Dilated-pupil acquisition. FOV: 50 degrees. Central posterior field. Camera: Topcon TRC-50DX. 2228 x 1652 pixels. CFP:
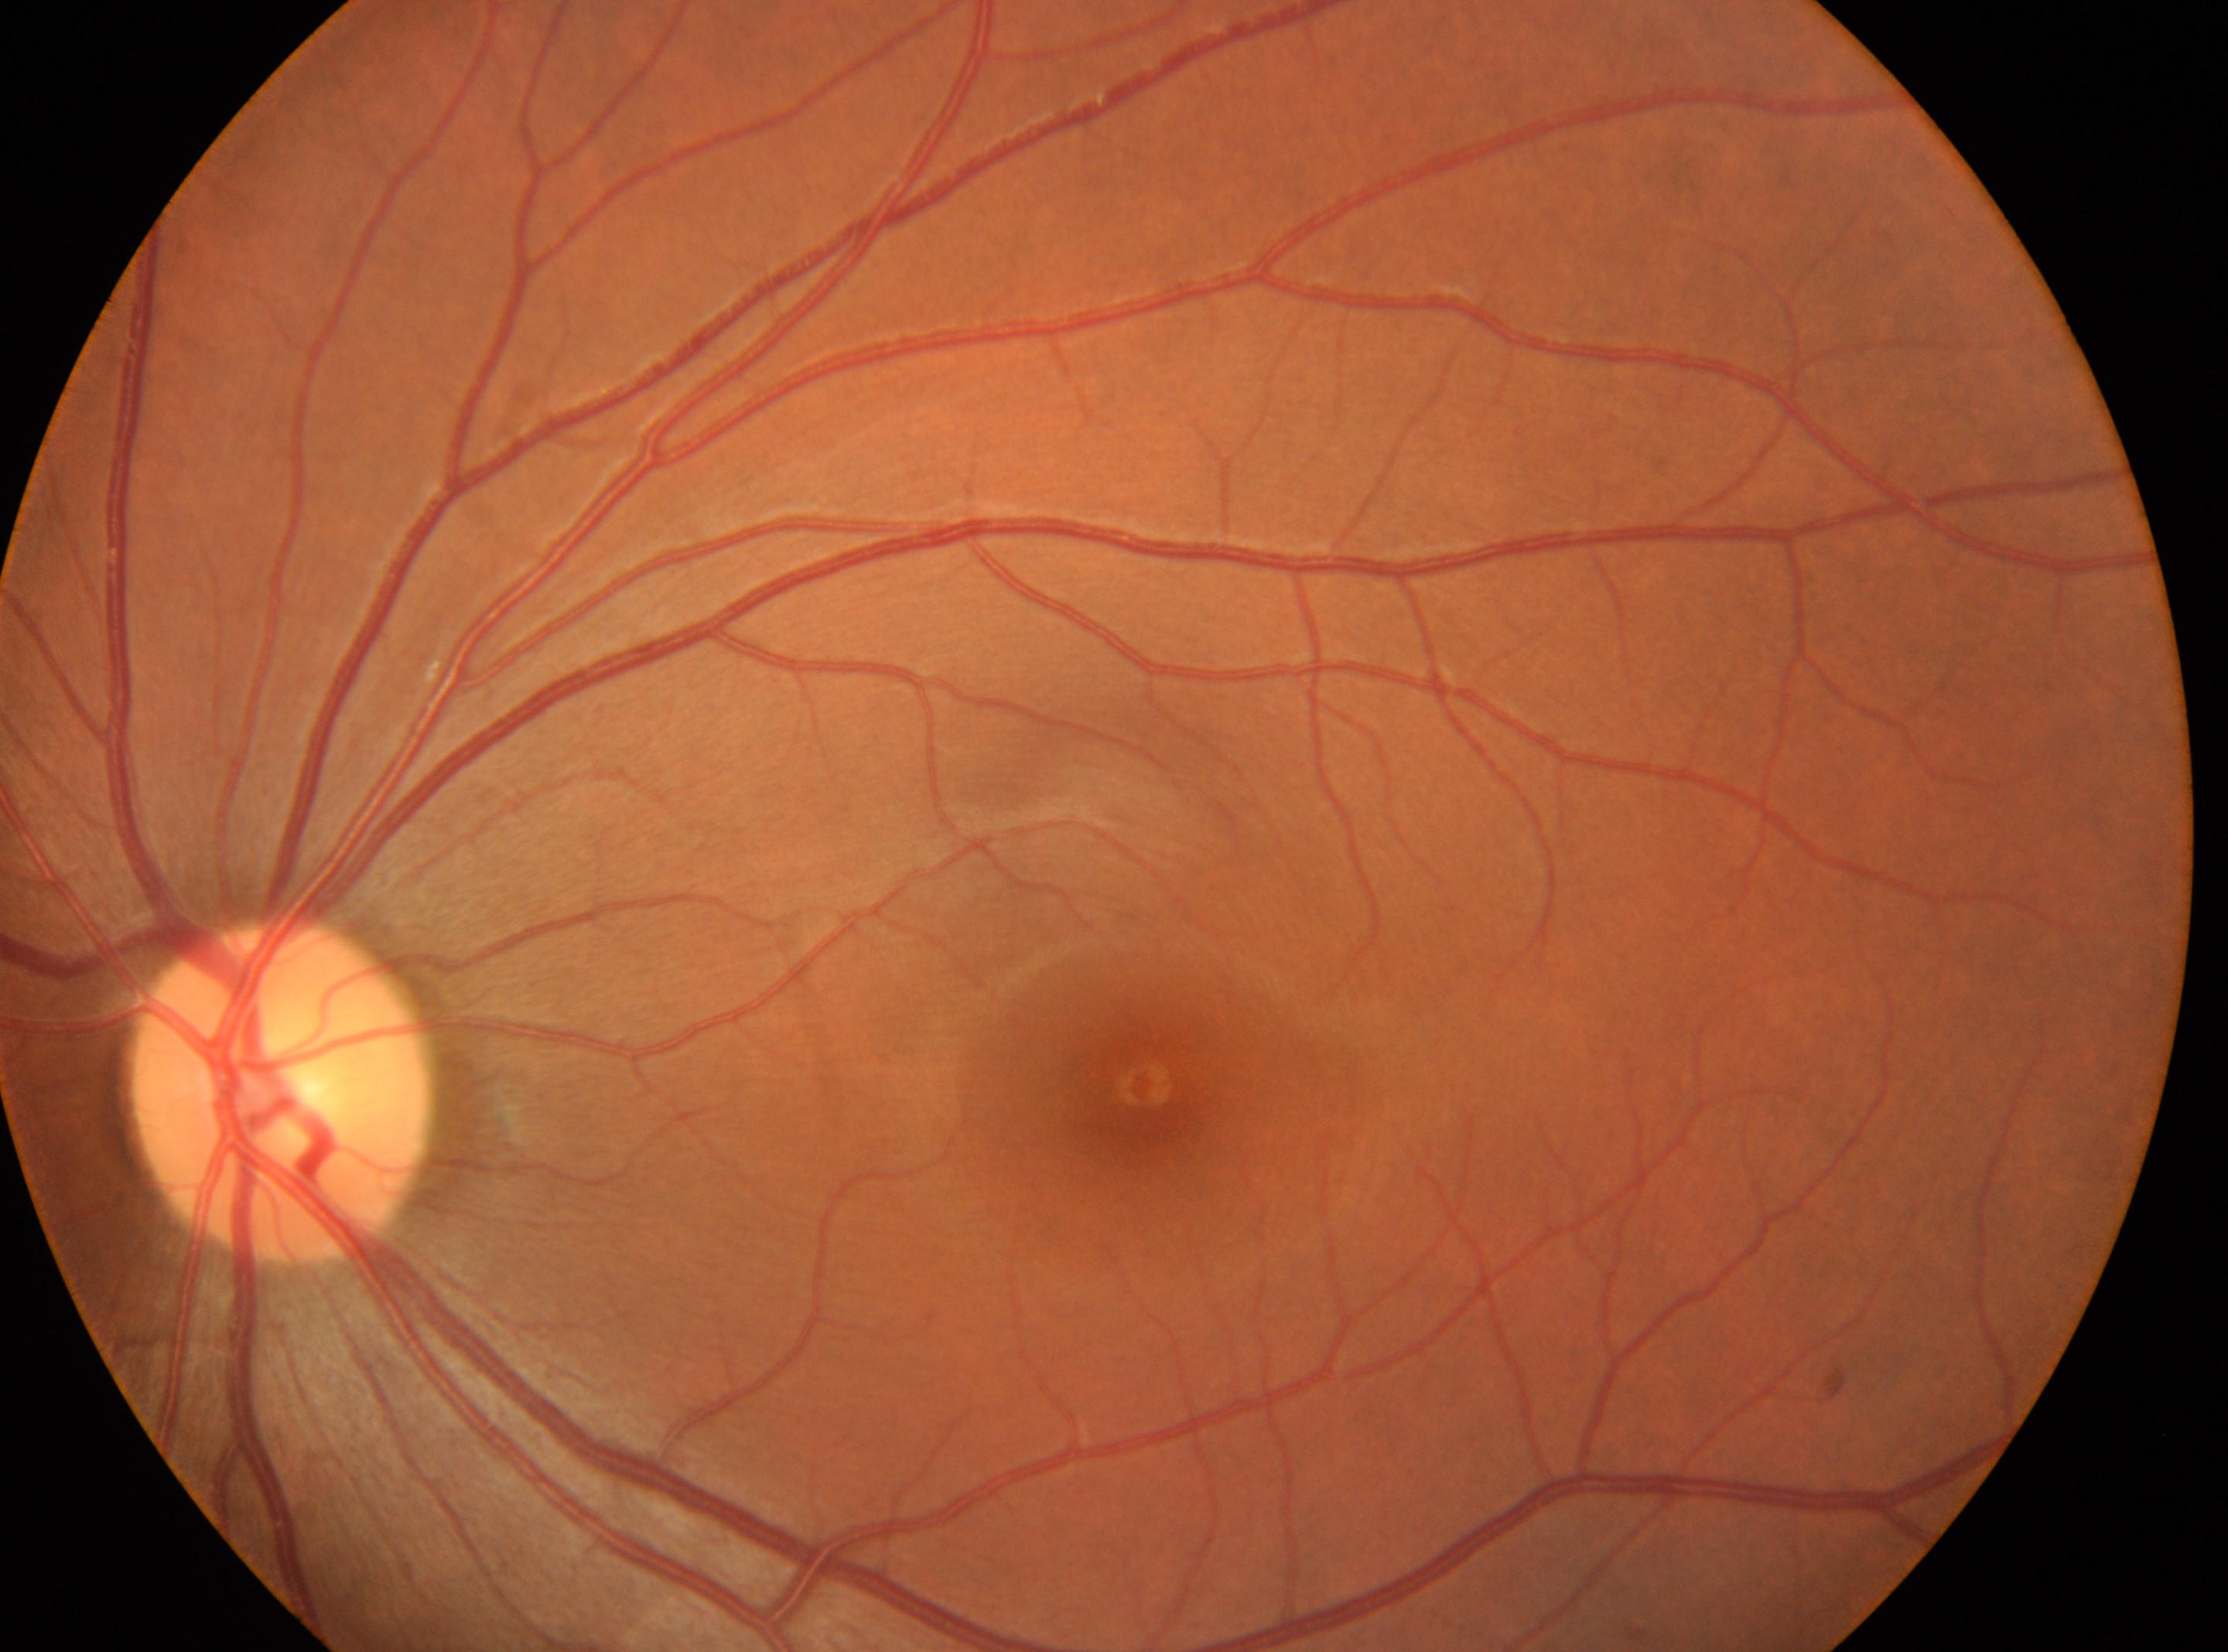

Diabetic retinopathy (DR) is 0.
Macular center located at 1142px, 1086px.
Optic disc center located at 280px, 1087px.
Imaged eye: oculus sinister.
No diabetic retinopathy identified.